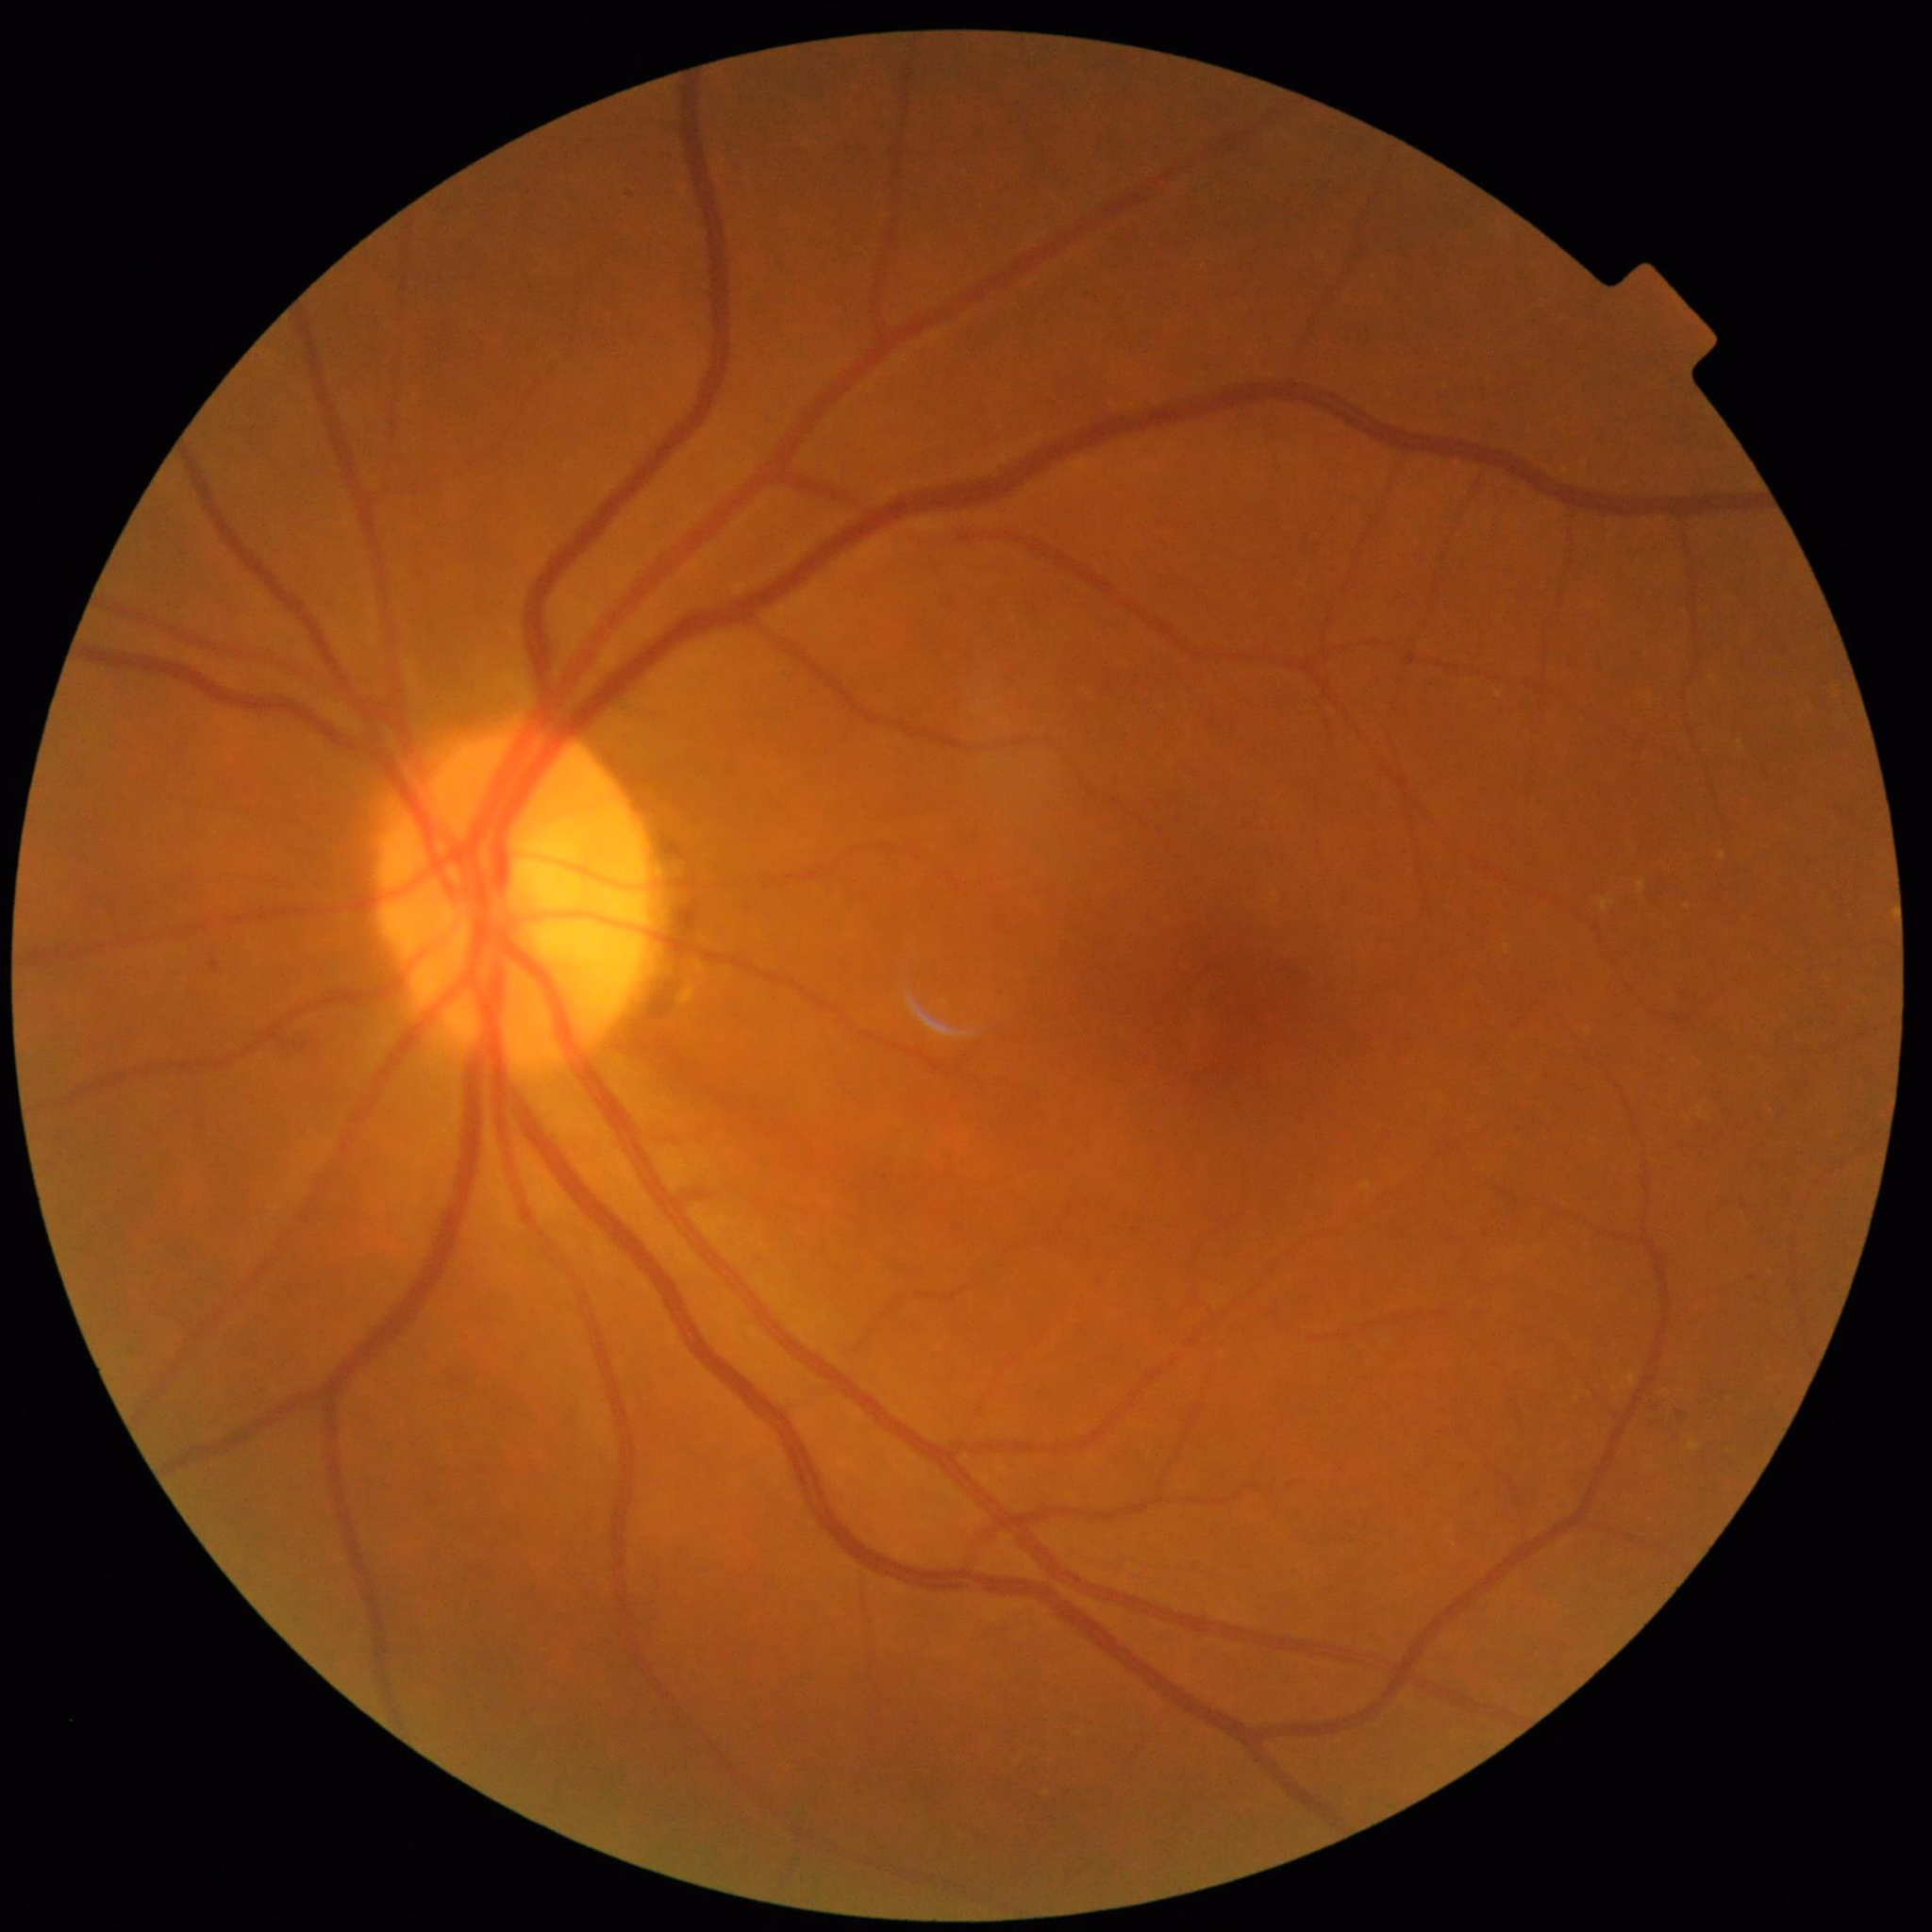

Disease = diabetic retinopathy.